Infant wide-field fundus photograph · 640x480.
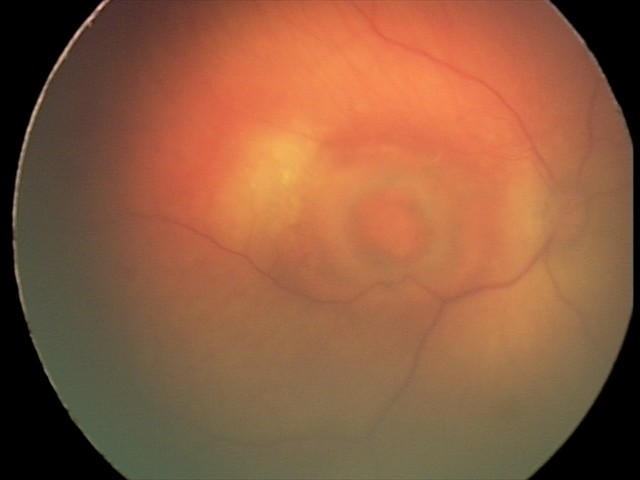 Impression: toxoplasmosis chorioretinitis.